Nonmydriatic; 45-degree field of view
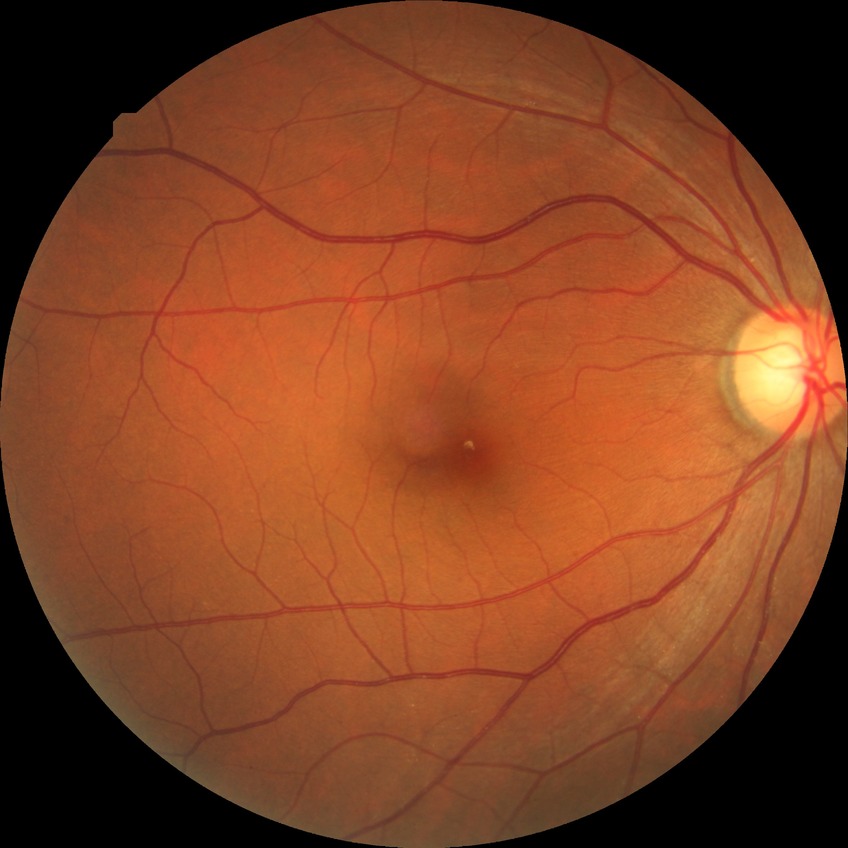
Findings:
- modified Davis grade — NDR